NIDEK AFC-230, 848x848, posterior pole color fundus photograph
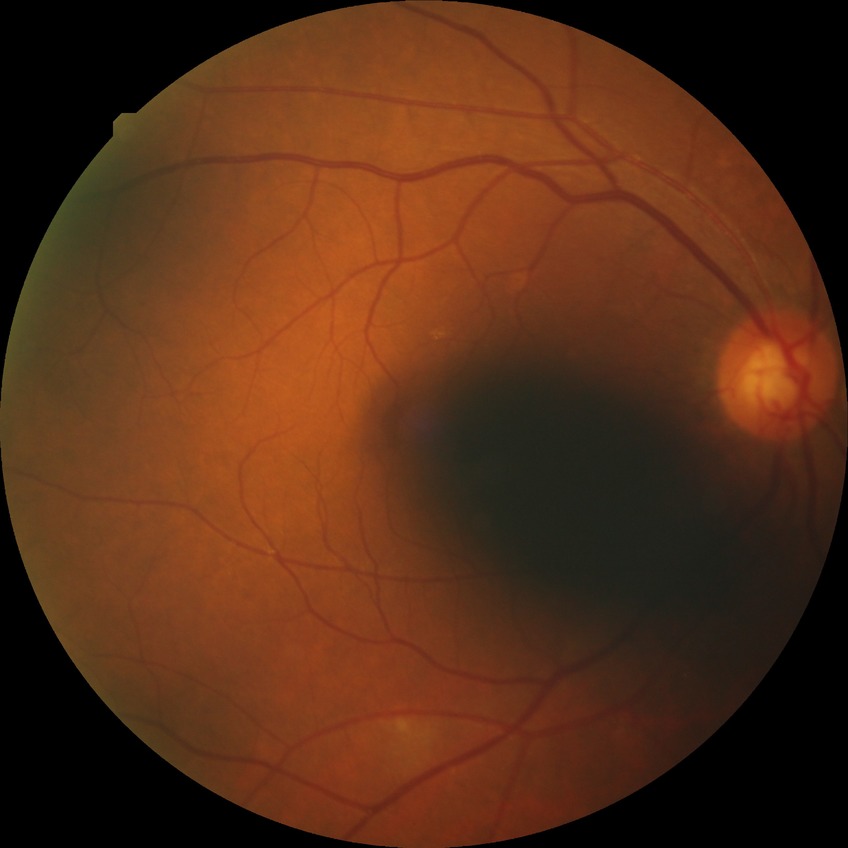 Diabetic retinopathy (DR) is NDR (no diabetic retinopathy).